Pediatric wide-field fundus photograph · image size 640x480: 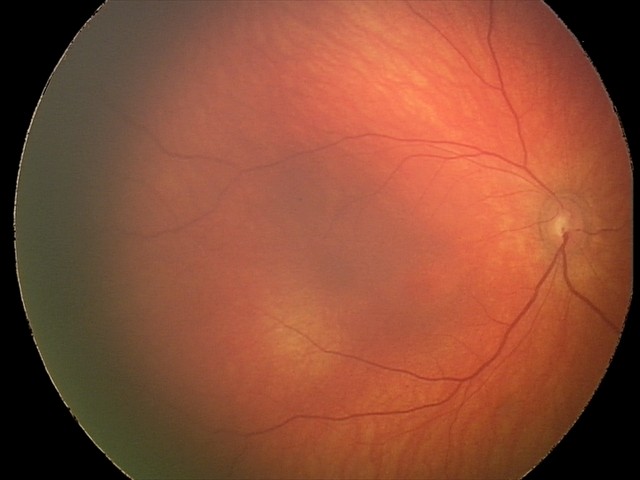 Examination diagnosed as retinal hemorrhages.